512 x 512 pixels. Color fundus image:
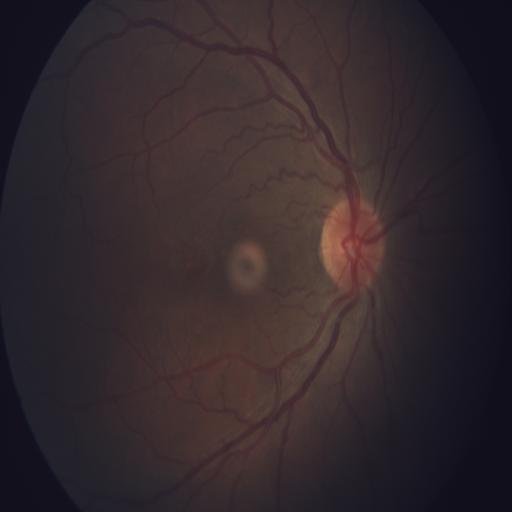 Abnormalities: media haze.